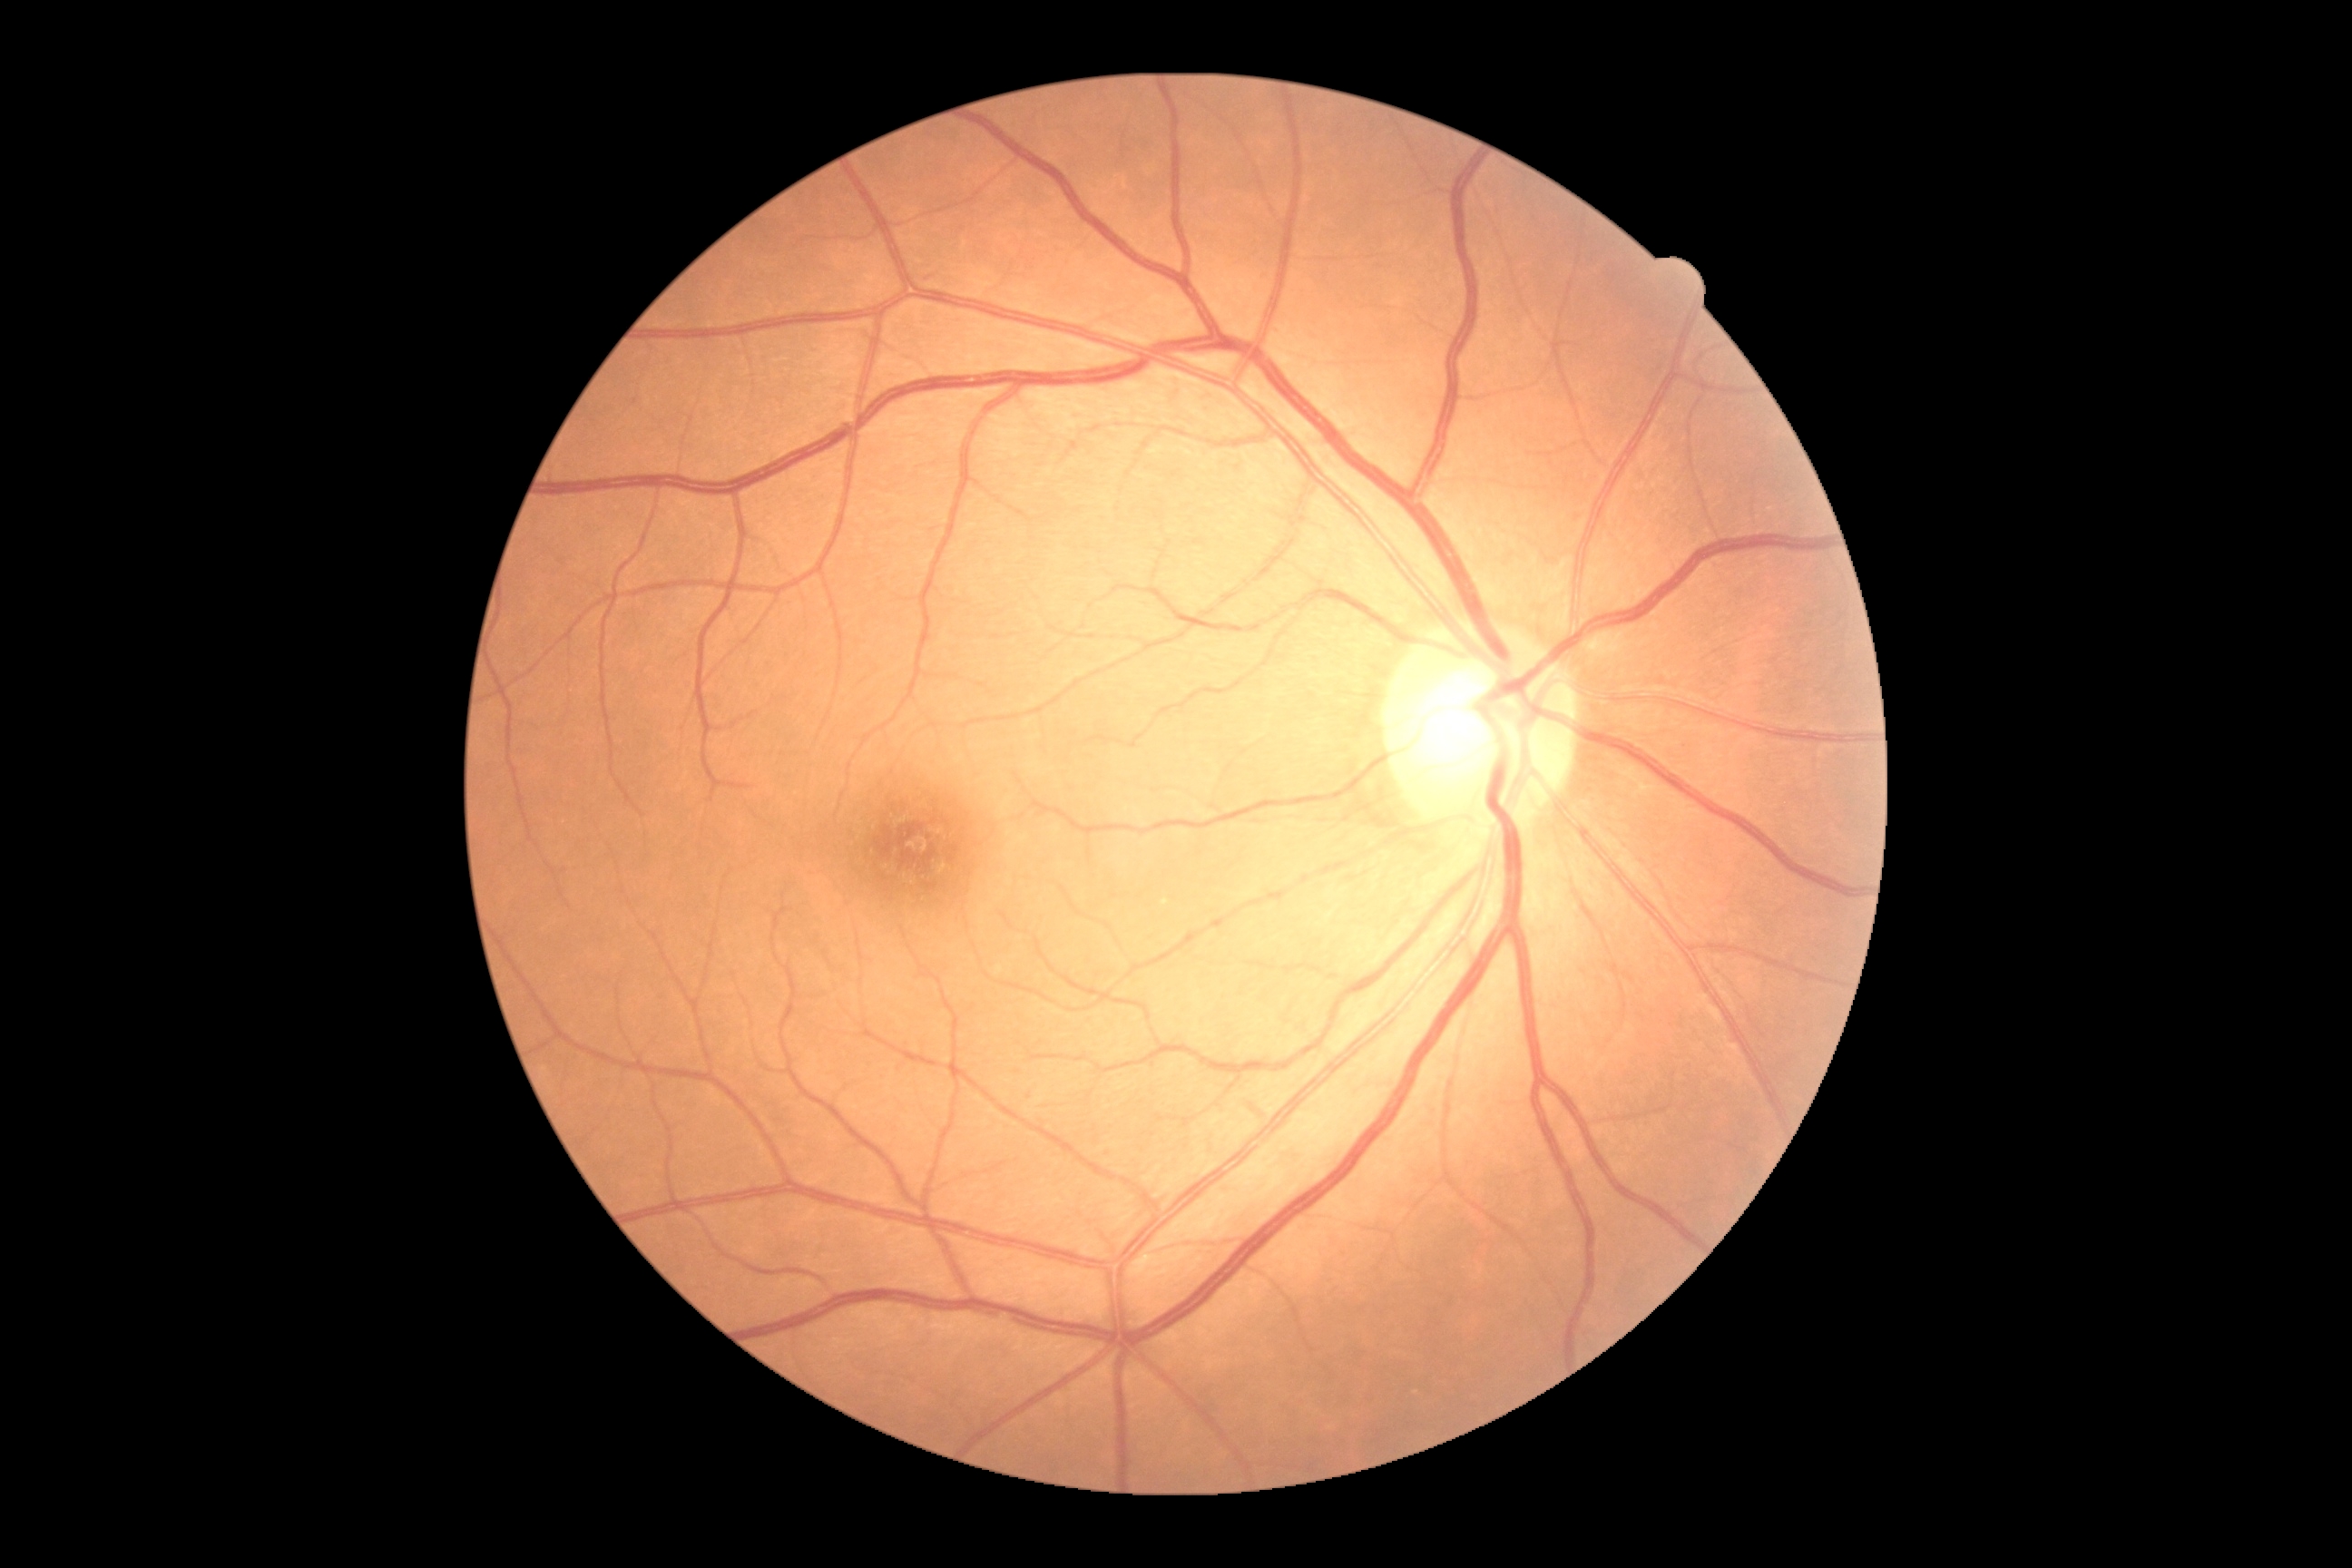 dr_grade: 0/4
dr_impression: negative for DR